Image size 640x480. Pediatric retinal photograph (wide-field):
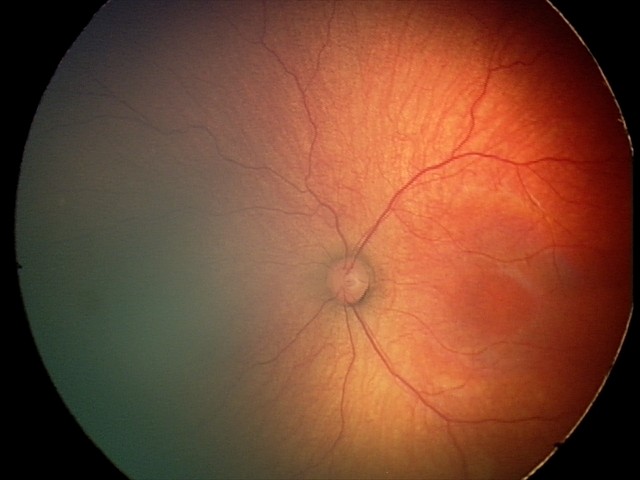

Q: What was the screening finding?
A: ROP stage 2